Infant wide-field retinal image.
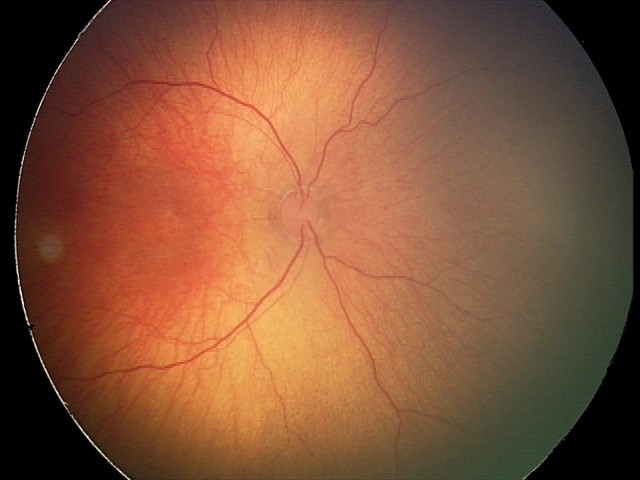
Screening series with status post retinopathy of prematurity (ROP) — retinal appearance after treated retinopathy of prematurity.